DR severity per modified Davis staging — 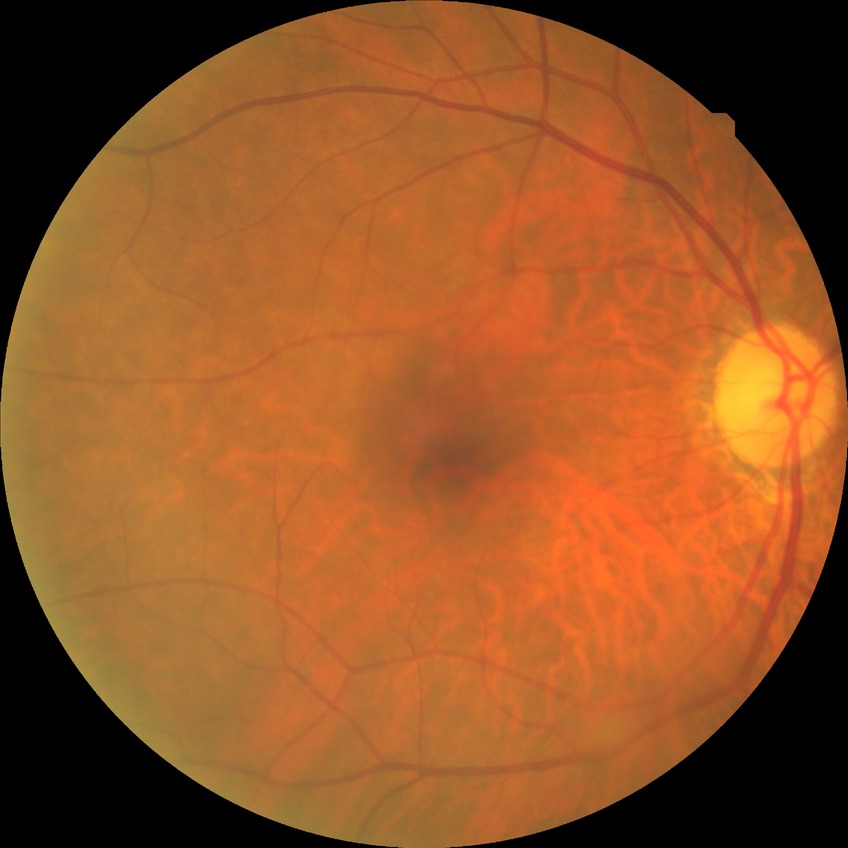

Diabetic retinopathy (DR): no diabetic retinopathy (NDR).